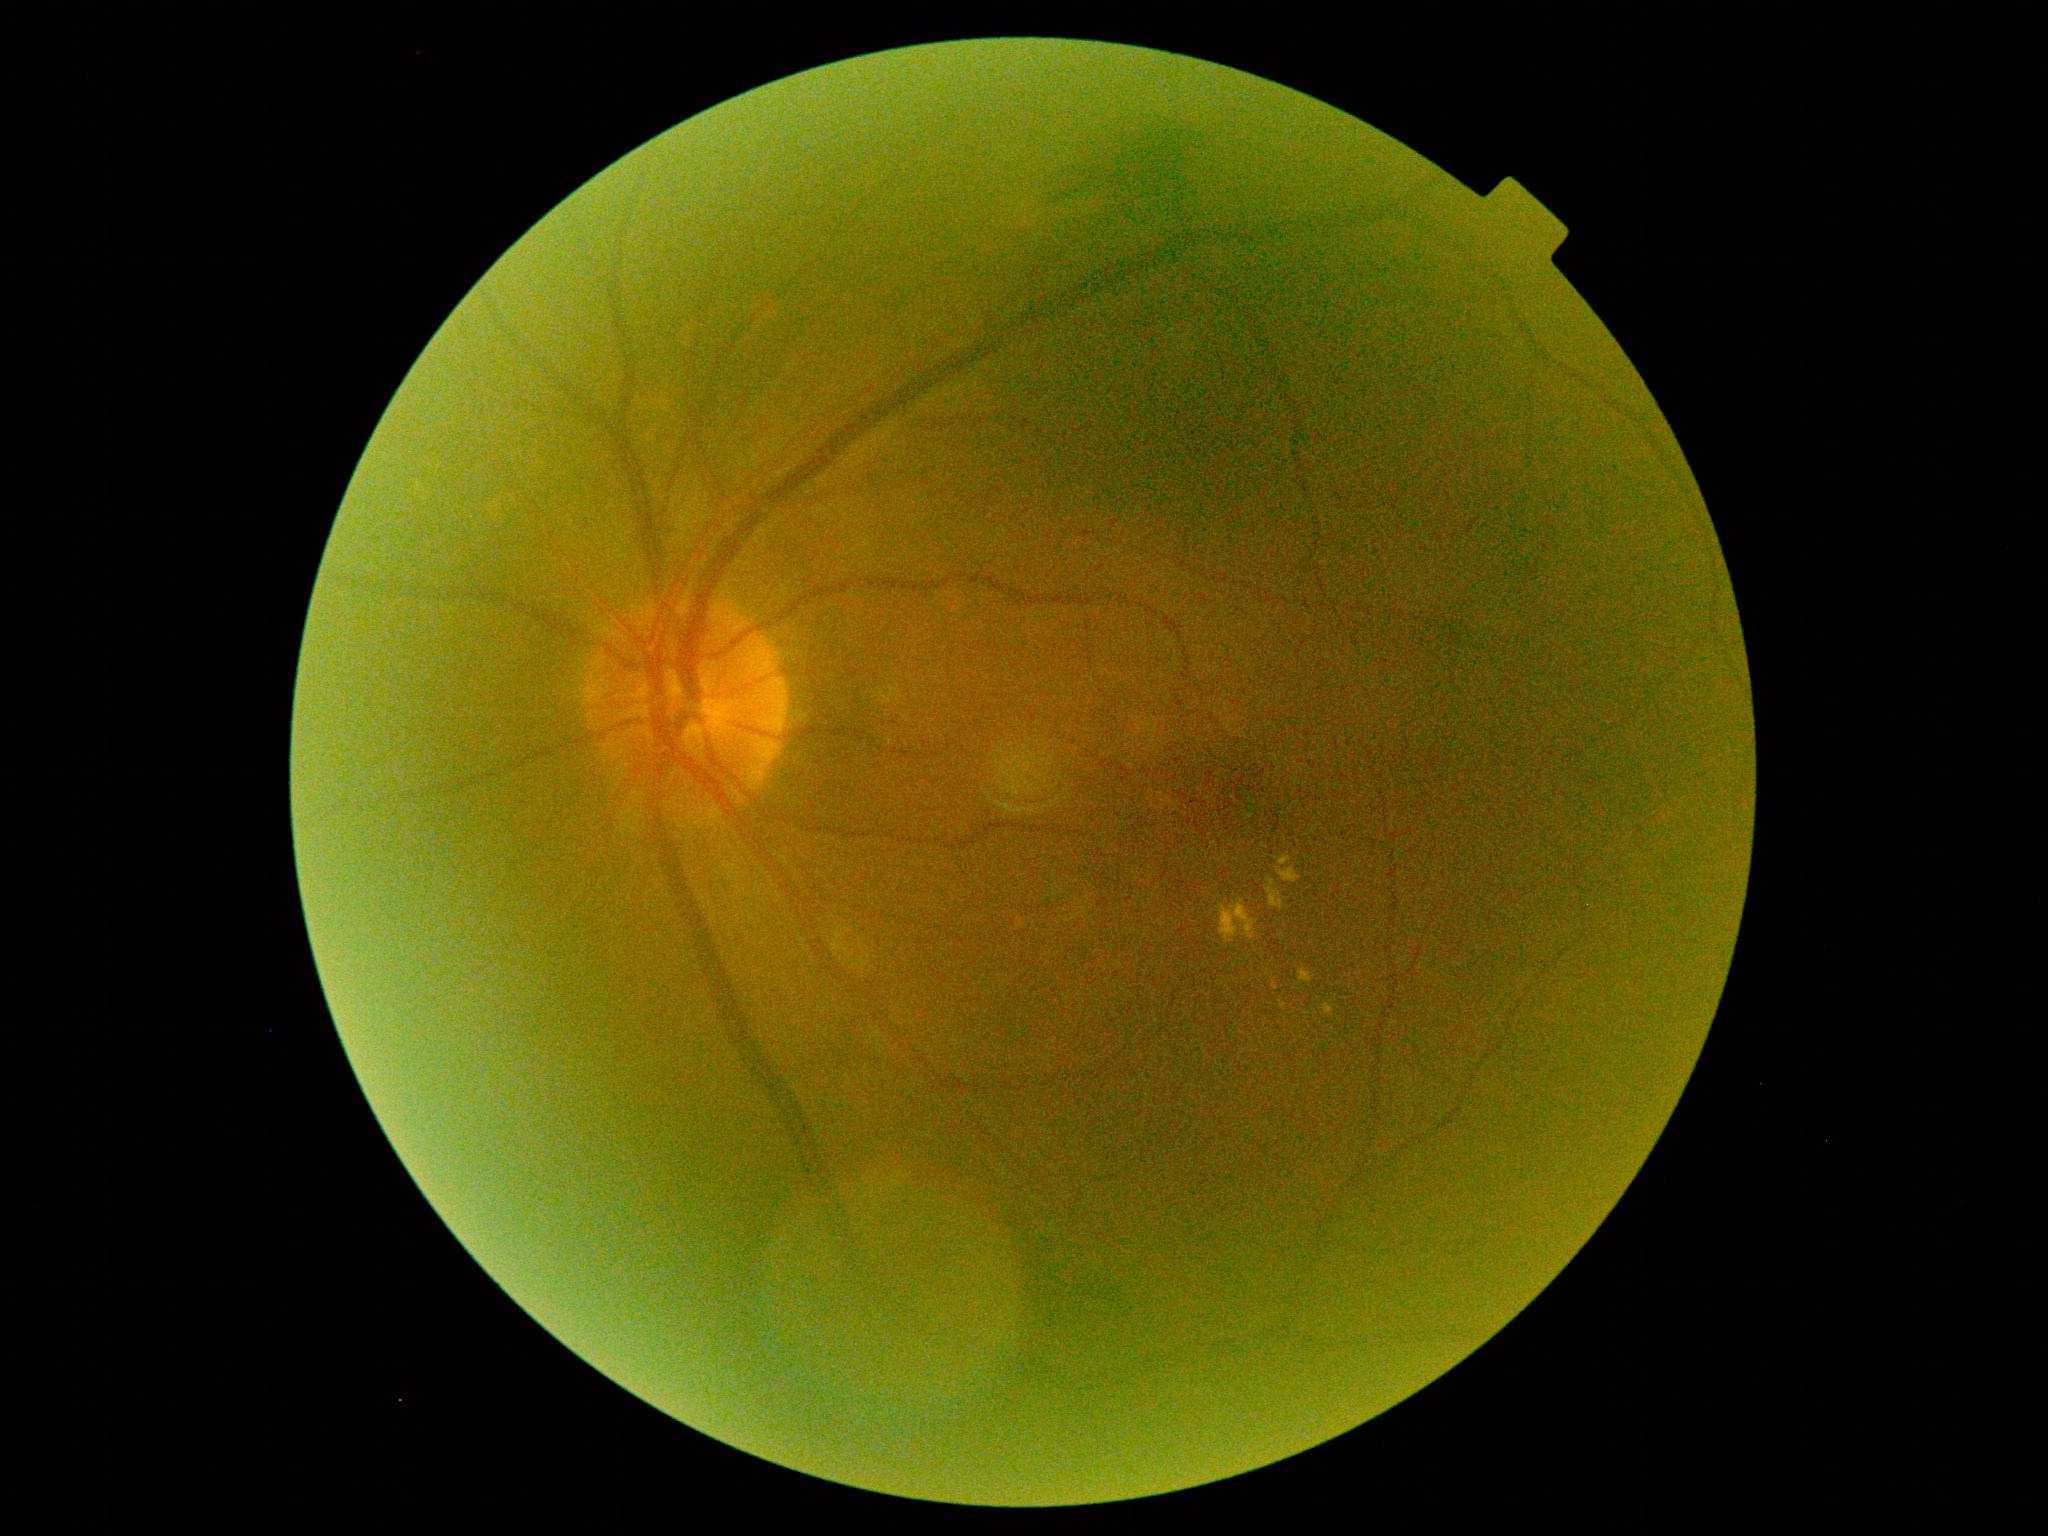

DR severity: grade 2.